Retinal fundus photograph. NIDEK AFC-230. 848 x 848 pixels. 45-degree field of view:
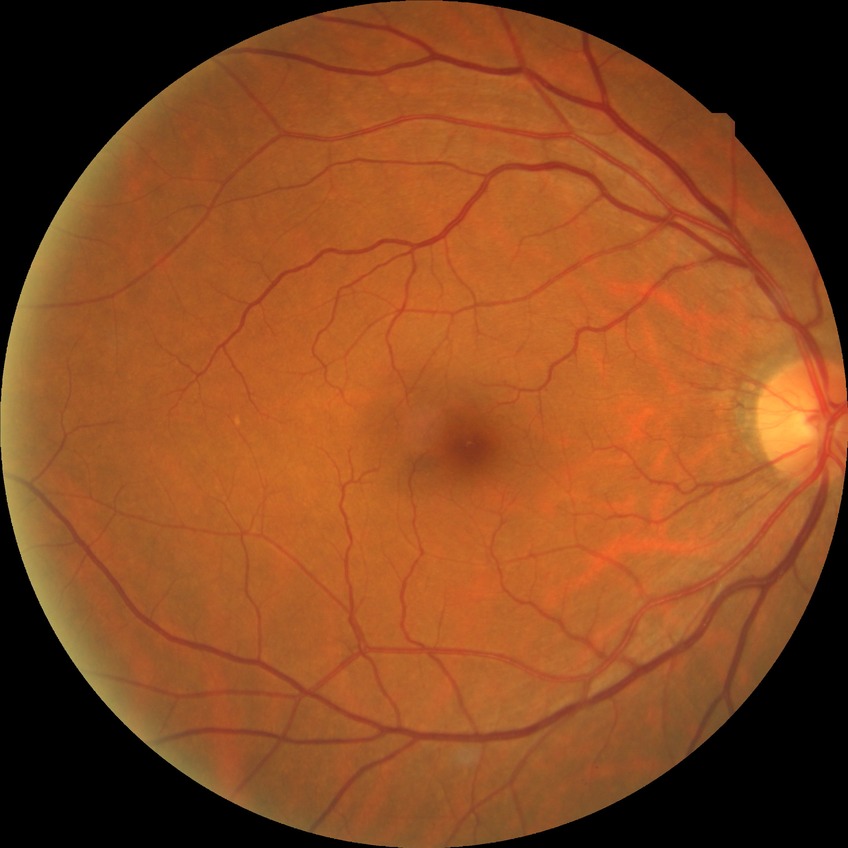
Modified Davis grading is no diabetic retinopathy.